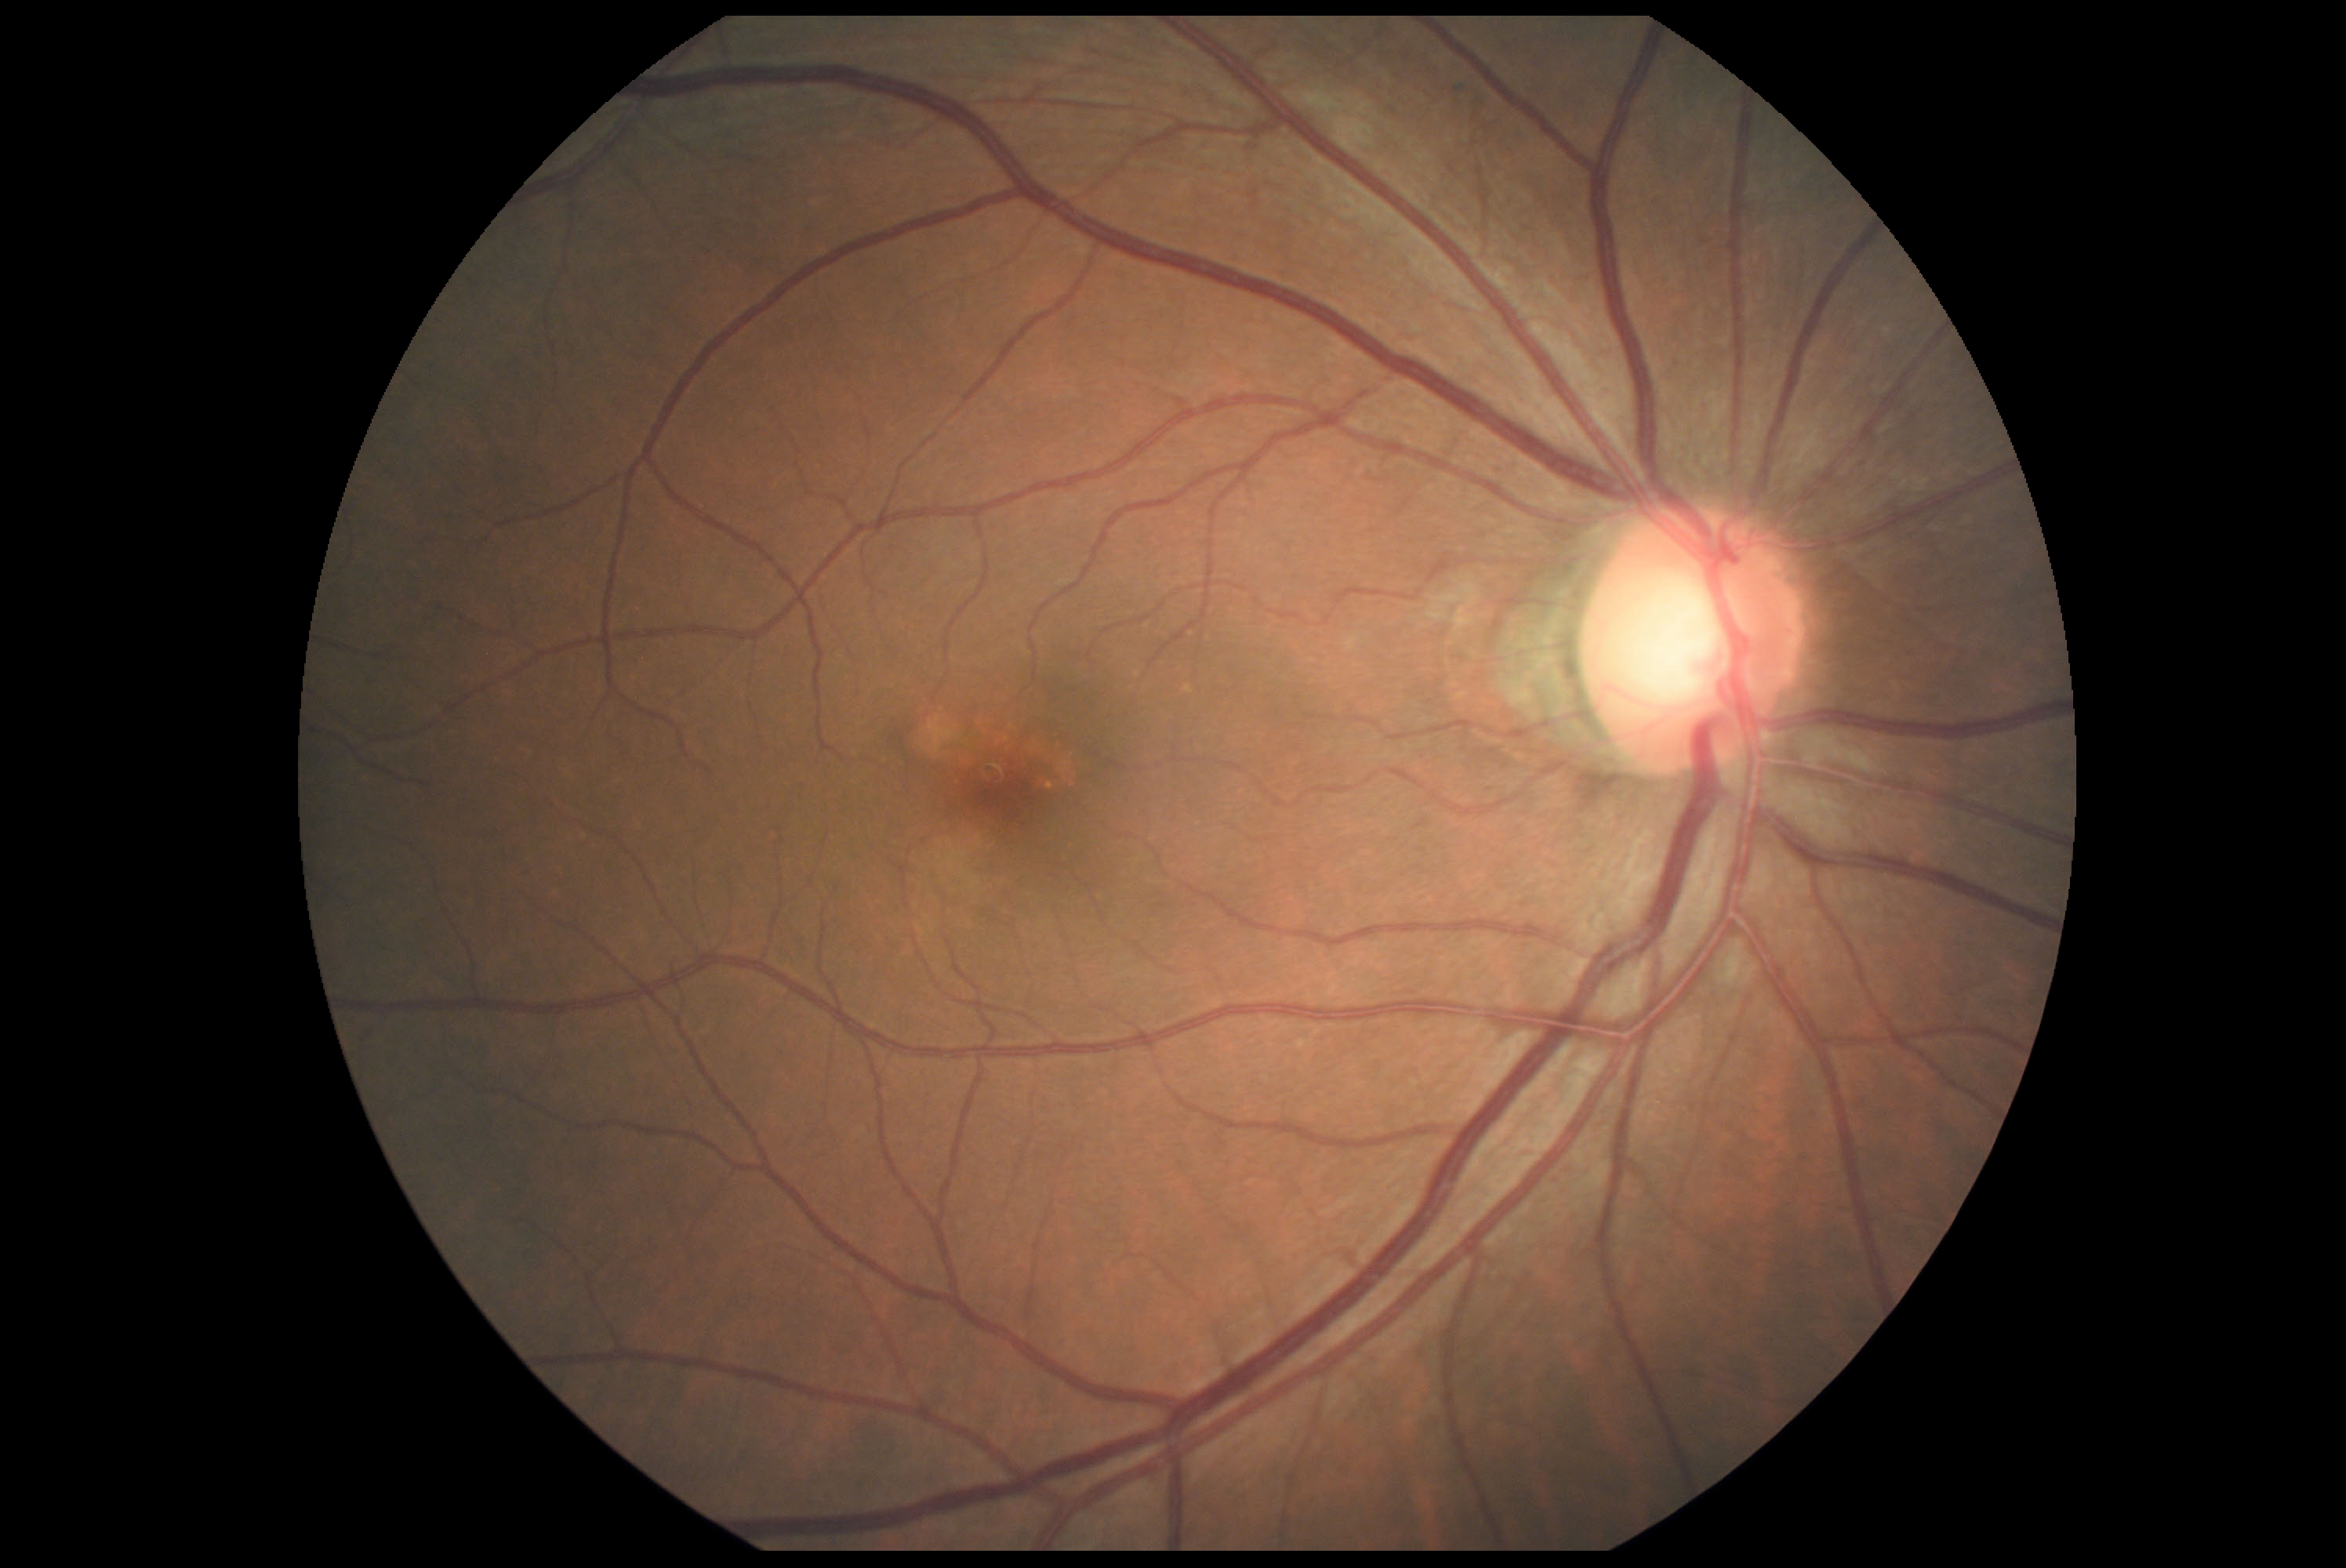

No signs of diabetic retinopathy. DR grade is 0.